Pediatric wide-field fundus photograph
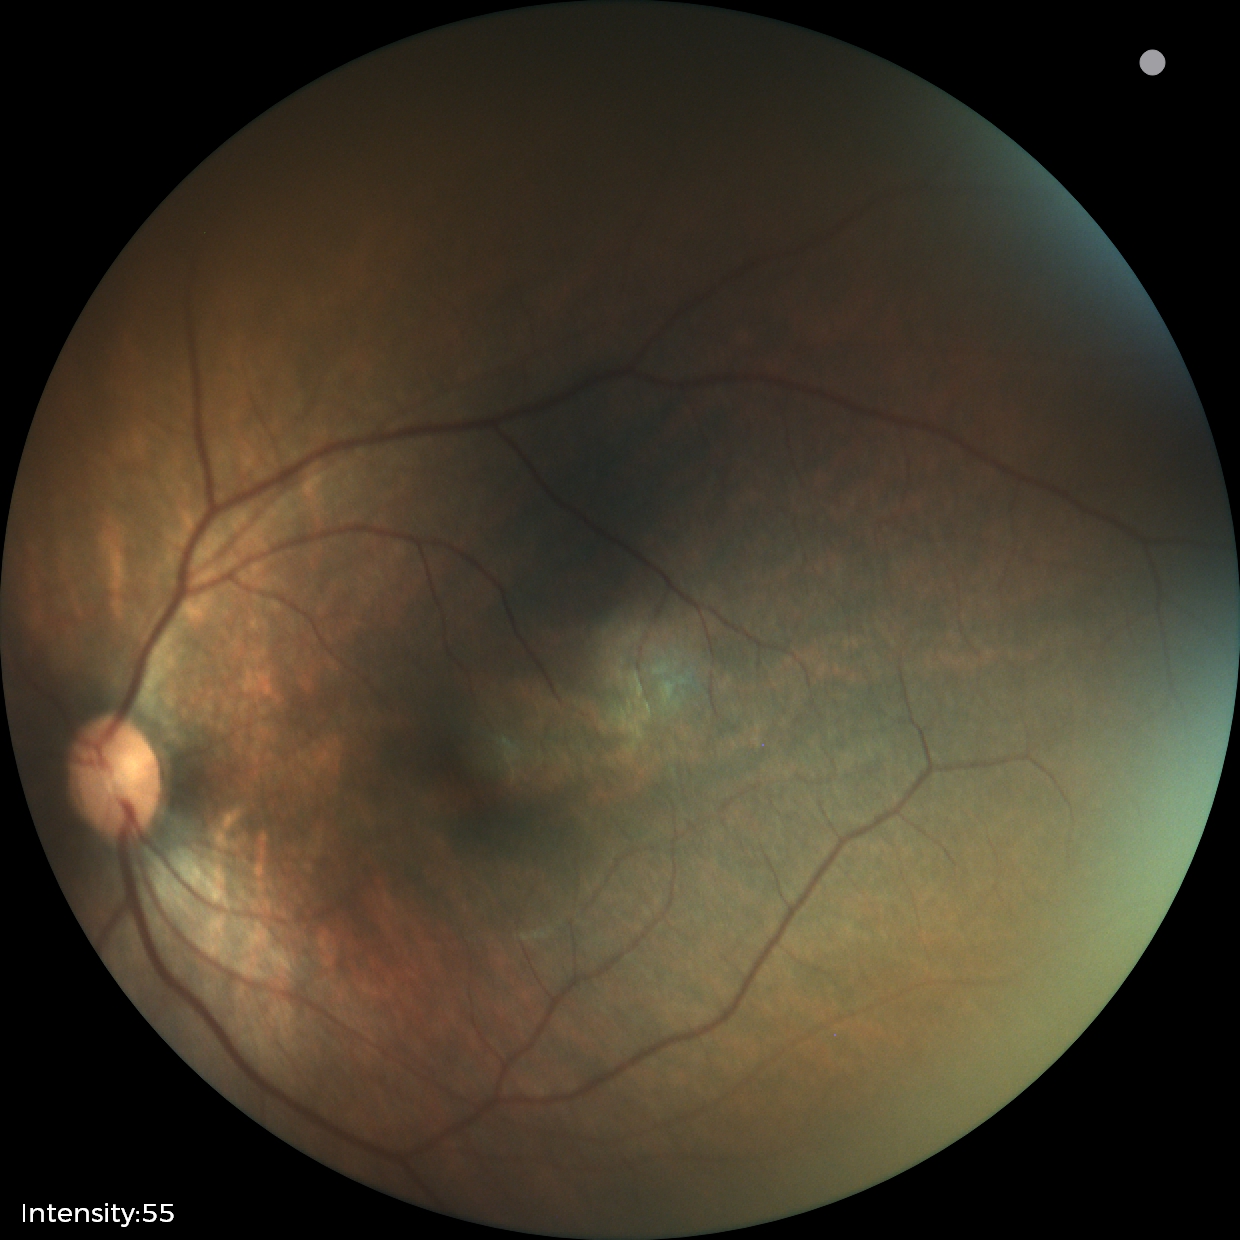
Finding: no pathology identified.